Pediatric retinal photograph (wide-field).
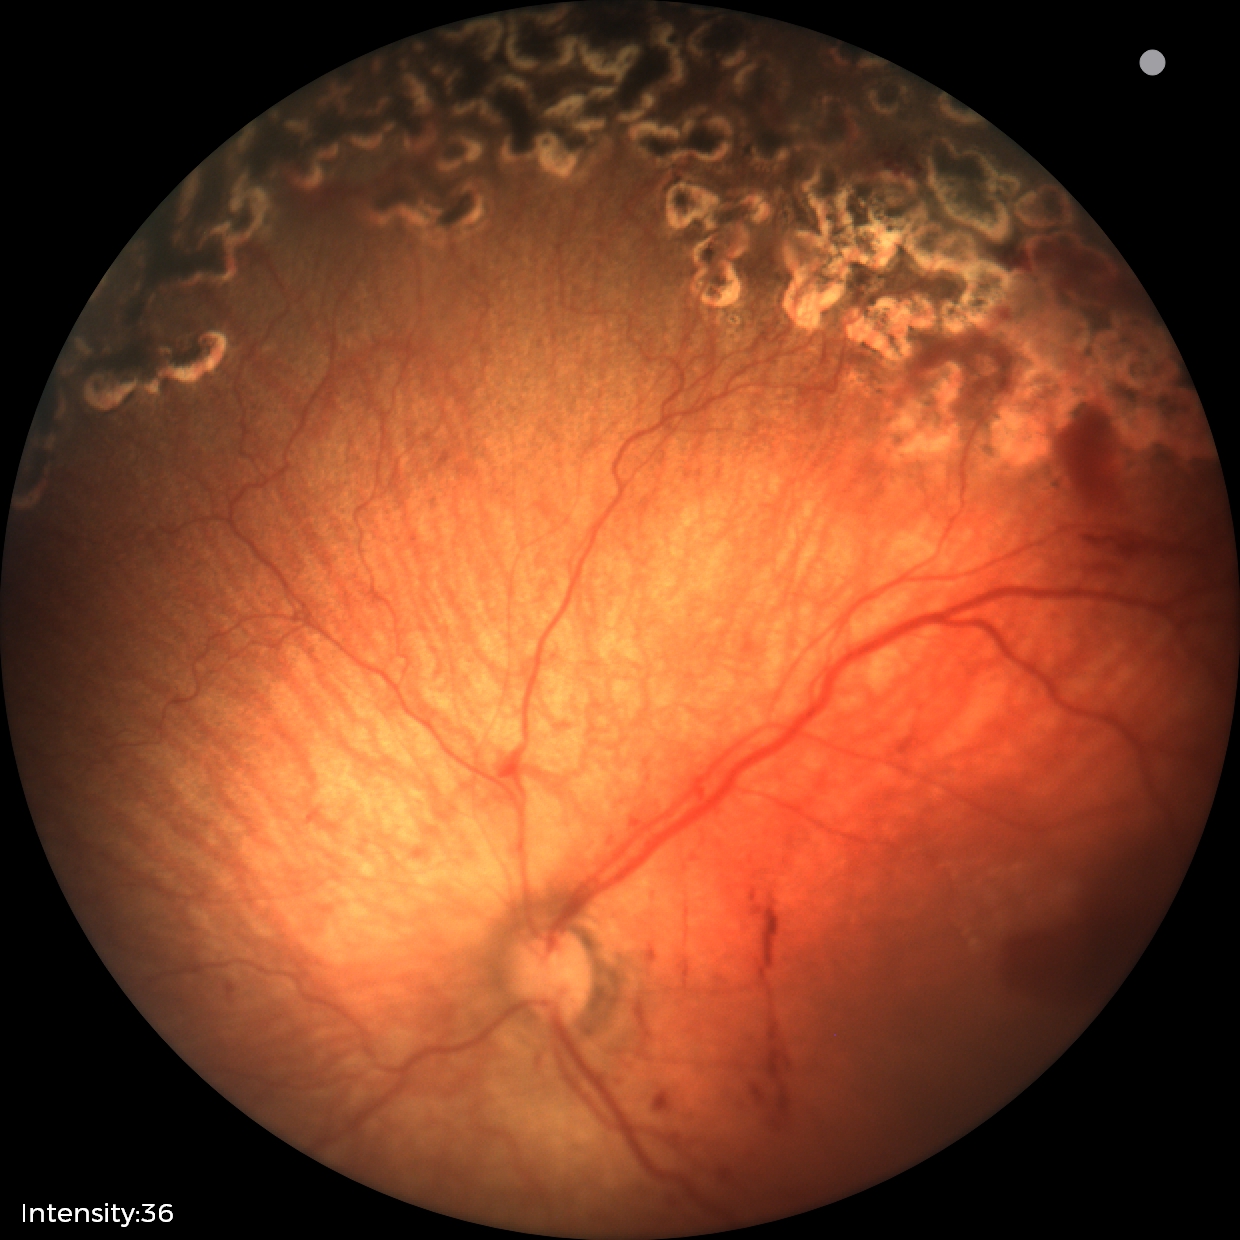
Series diagnosed as status post ROP. Without plus disease.